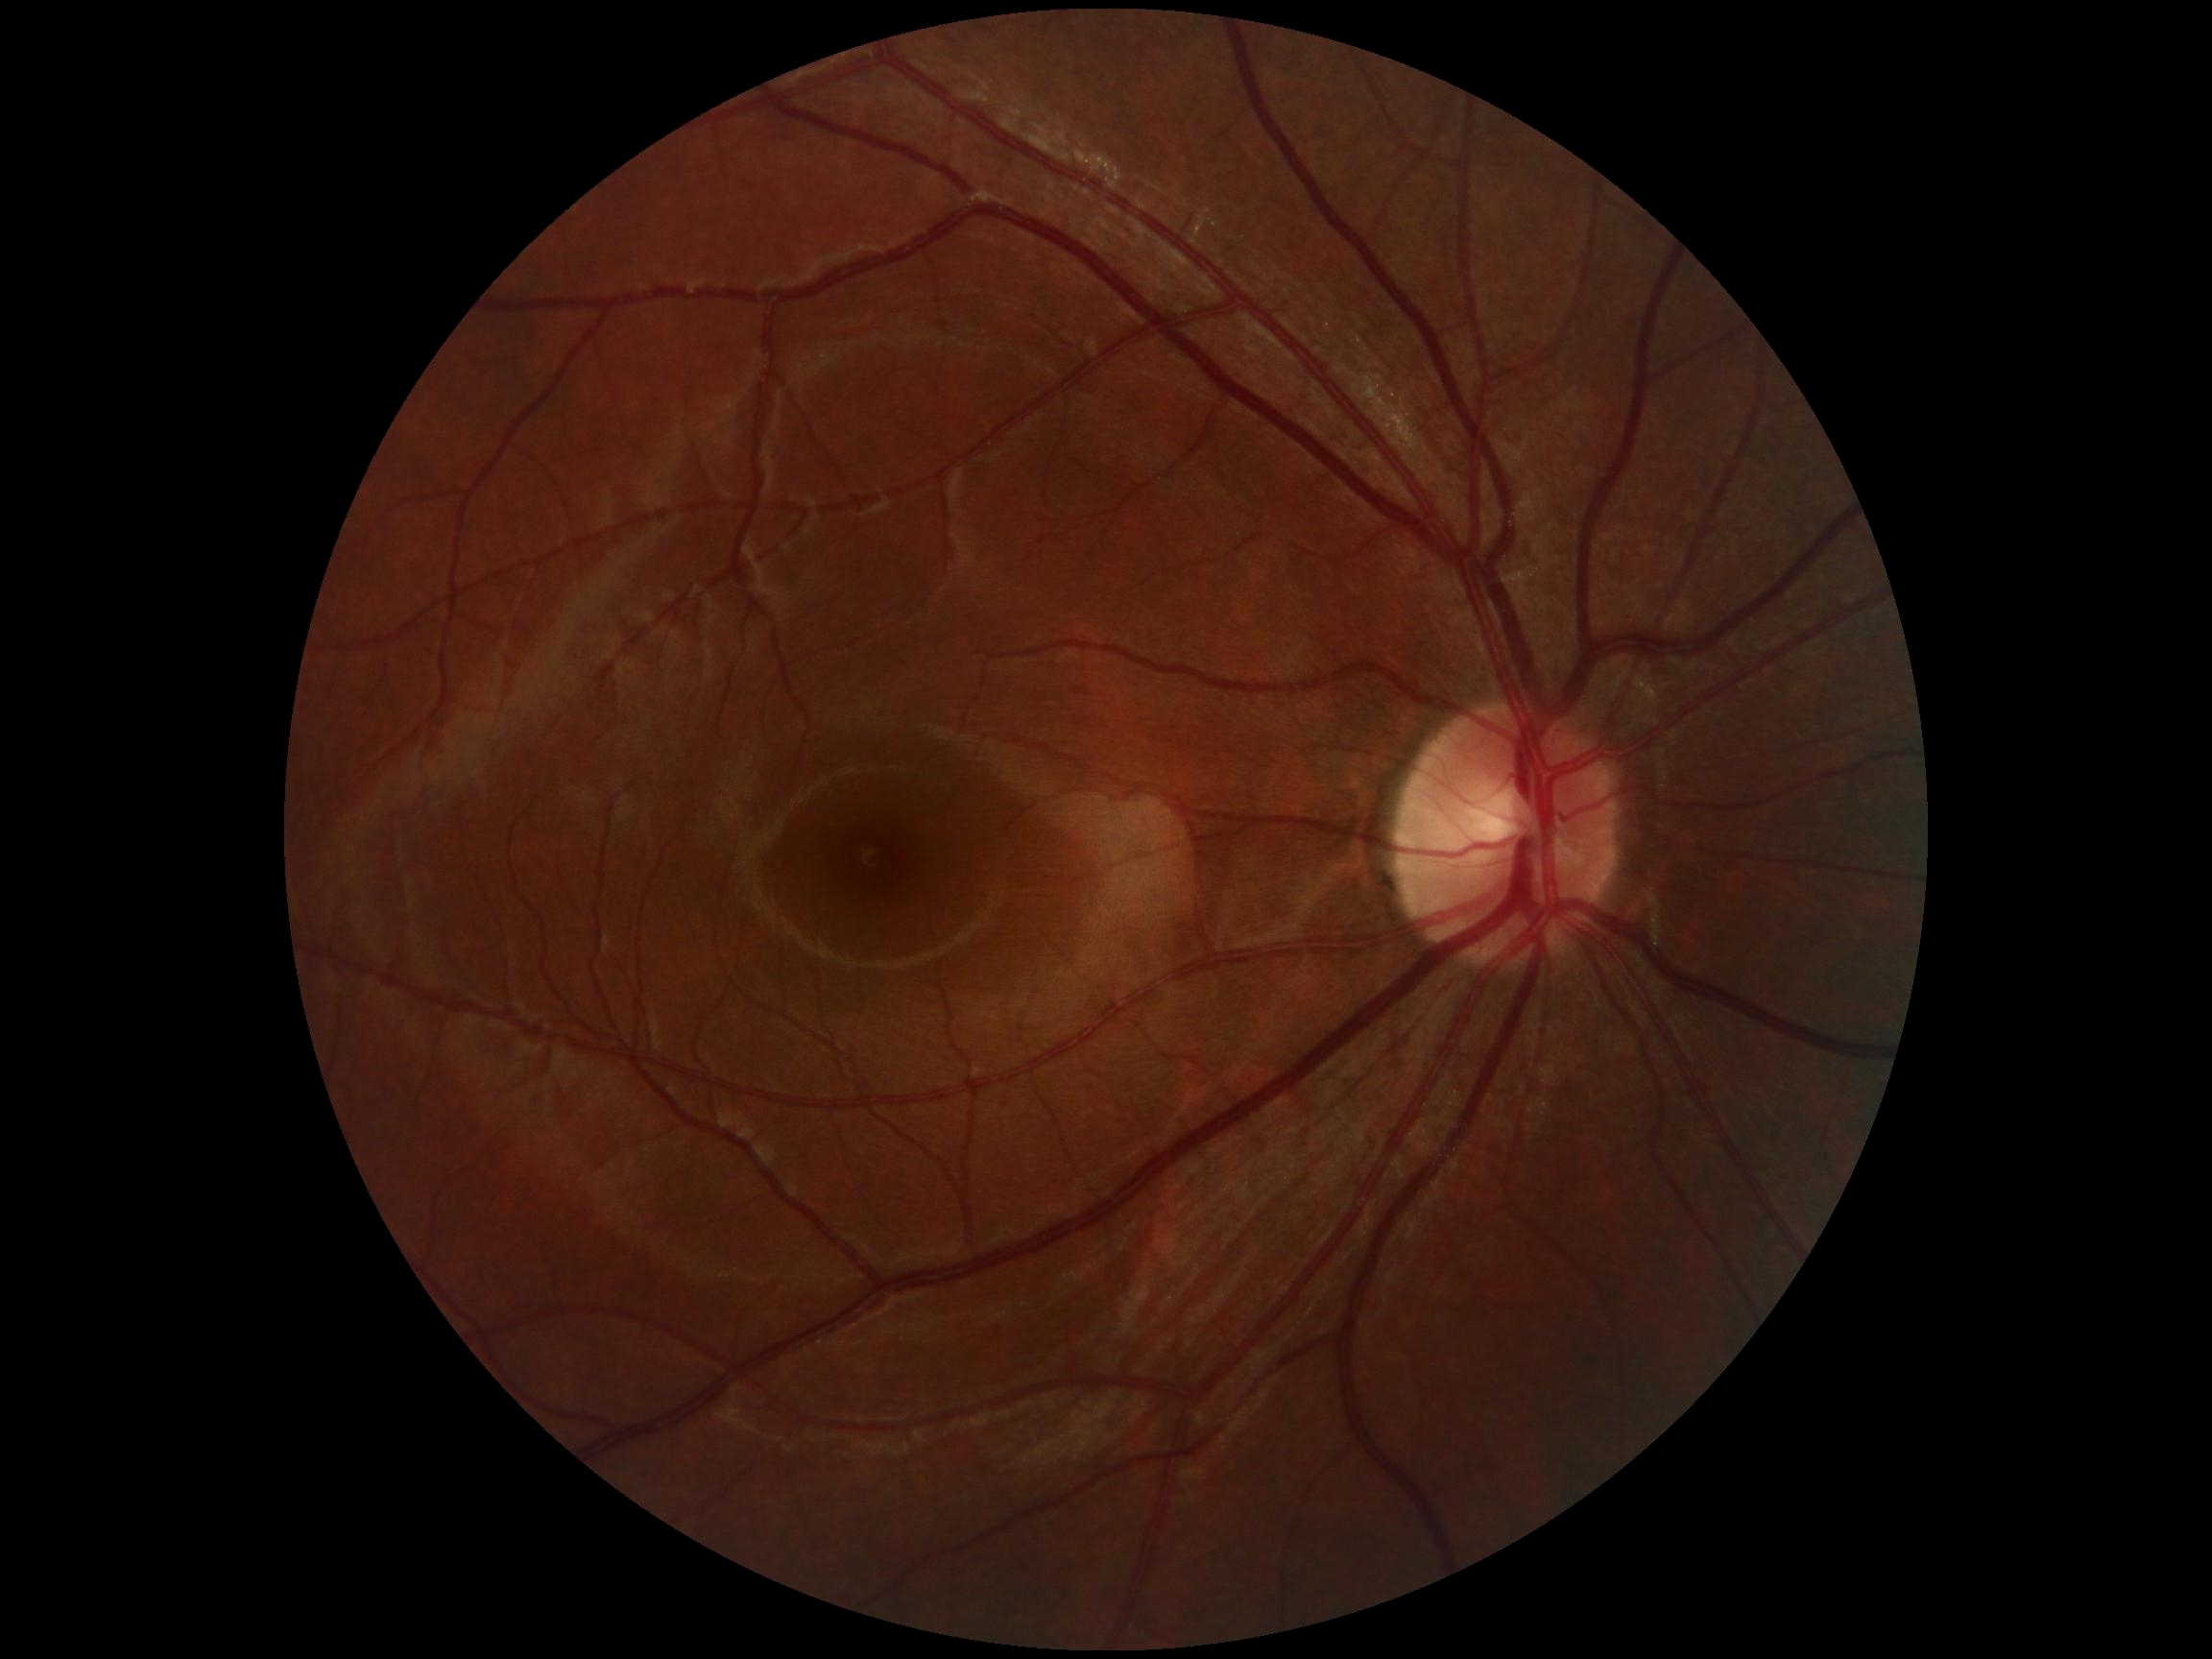 {"dr_grade": "no apparent retinopathy (0)"}